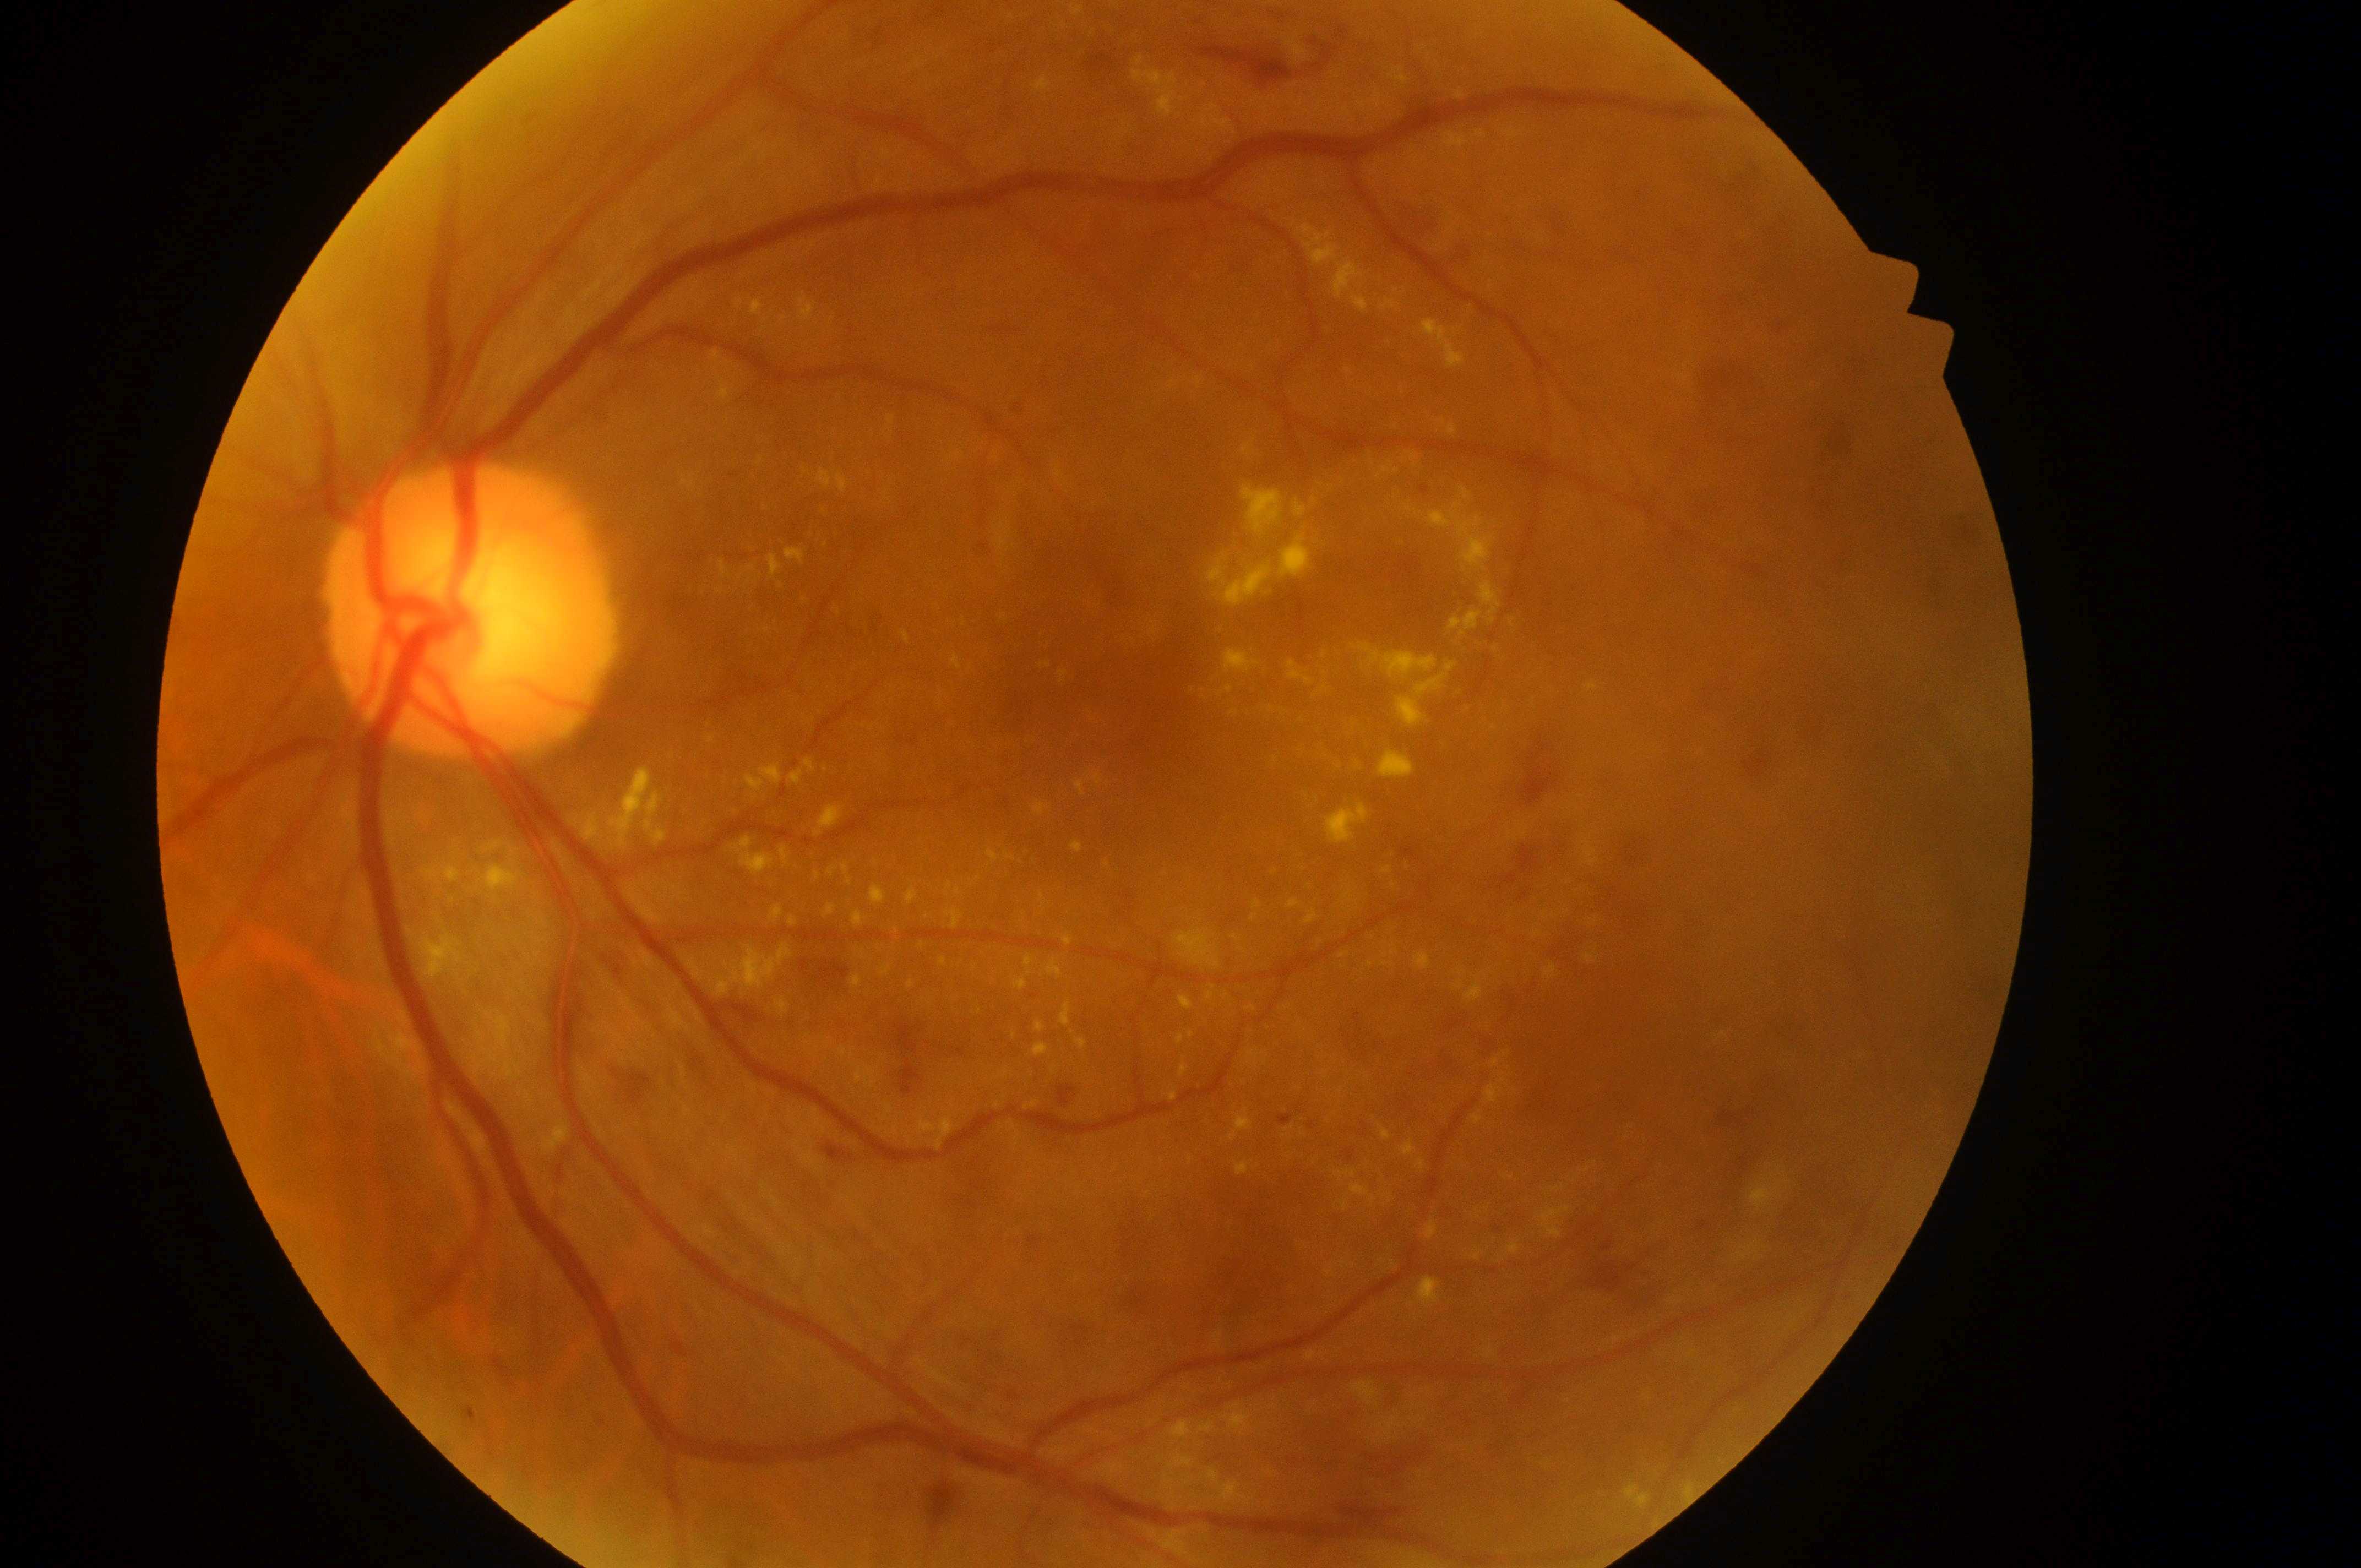
Optic nerve head located at 460px, 616px. The image shows the left eye. Foveal center located at 1112px, 713px. DME risk: high risk (grade 2). DR: grade 3 (severe NPDR).